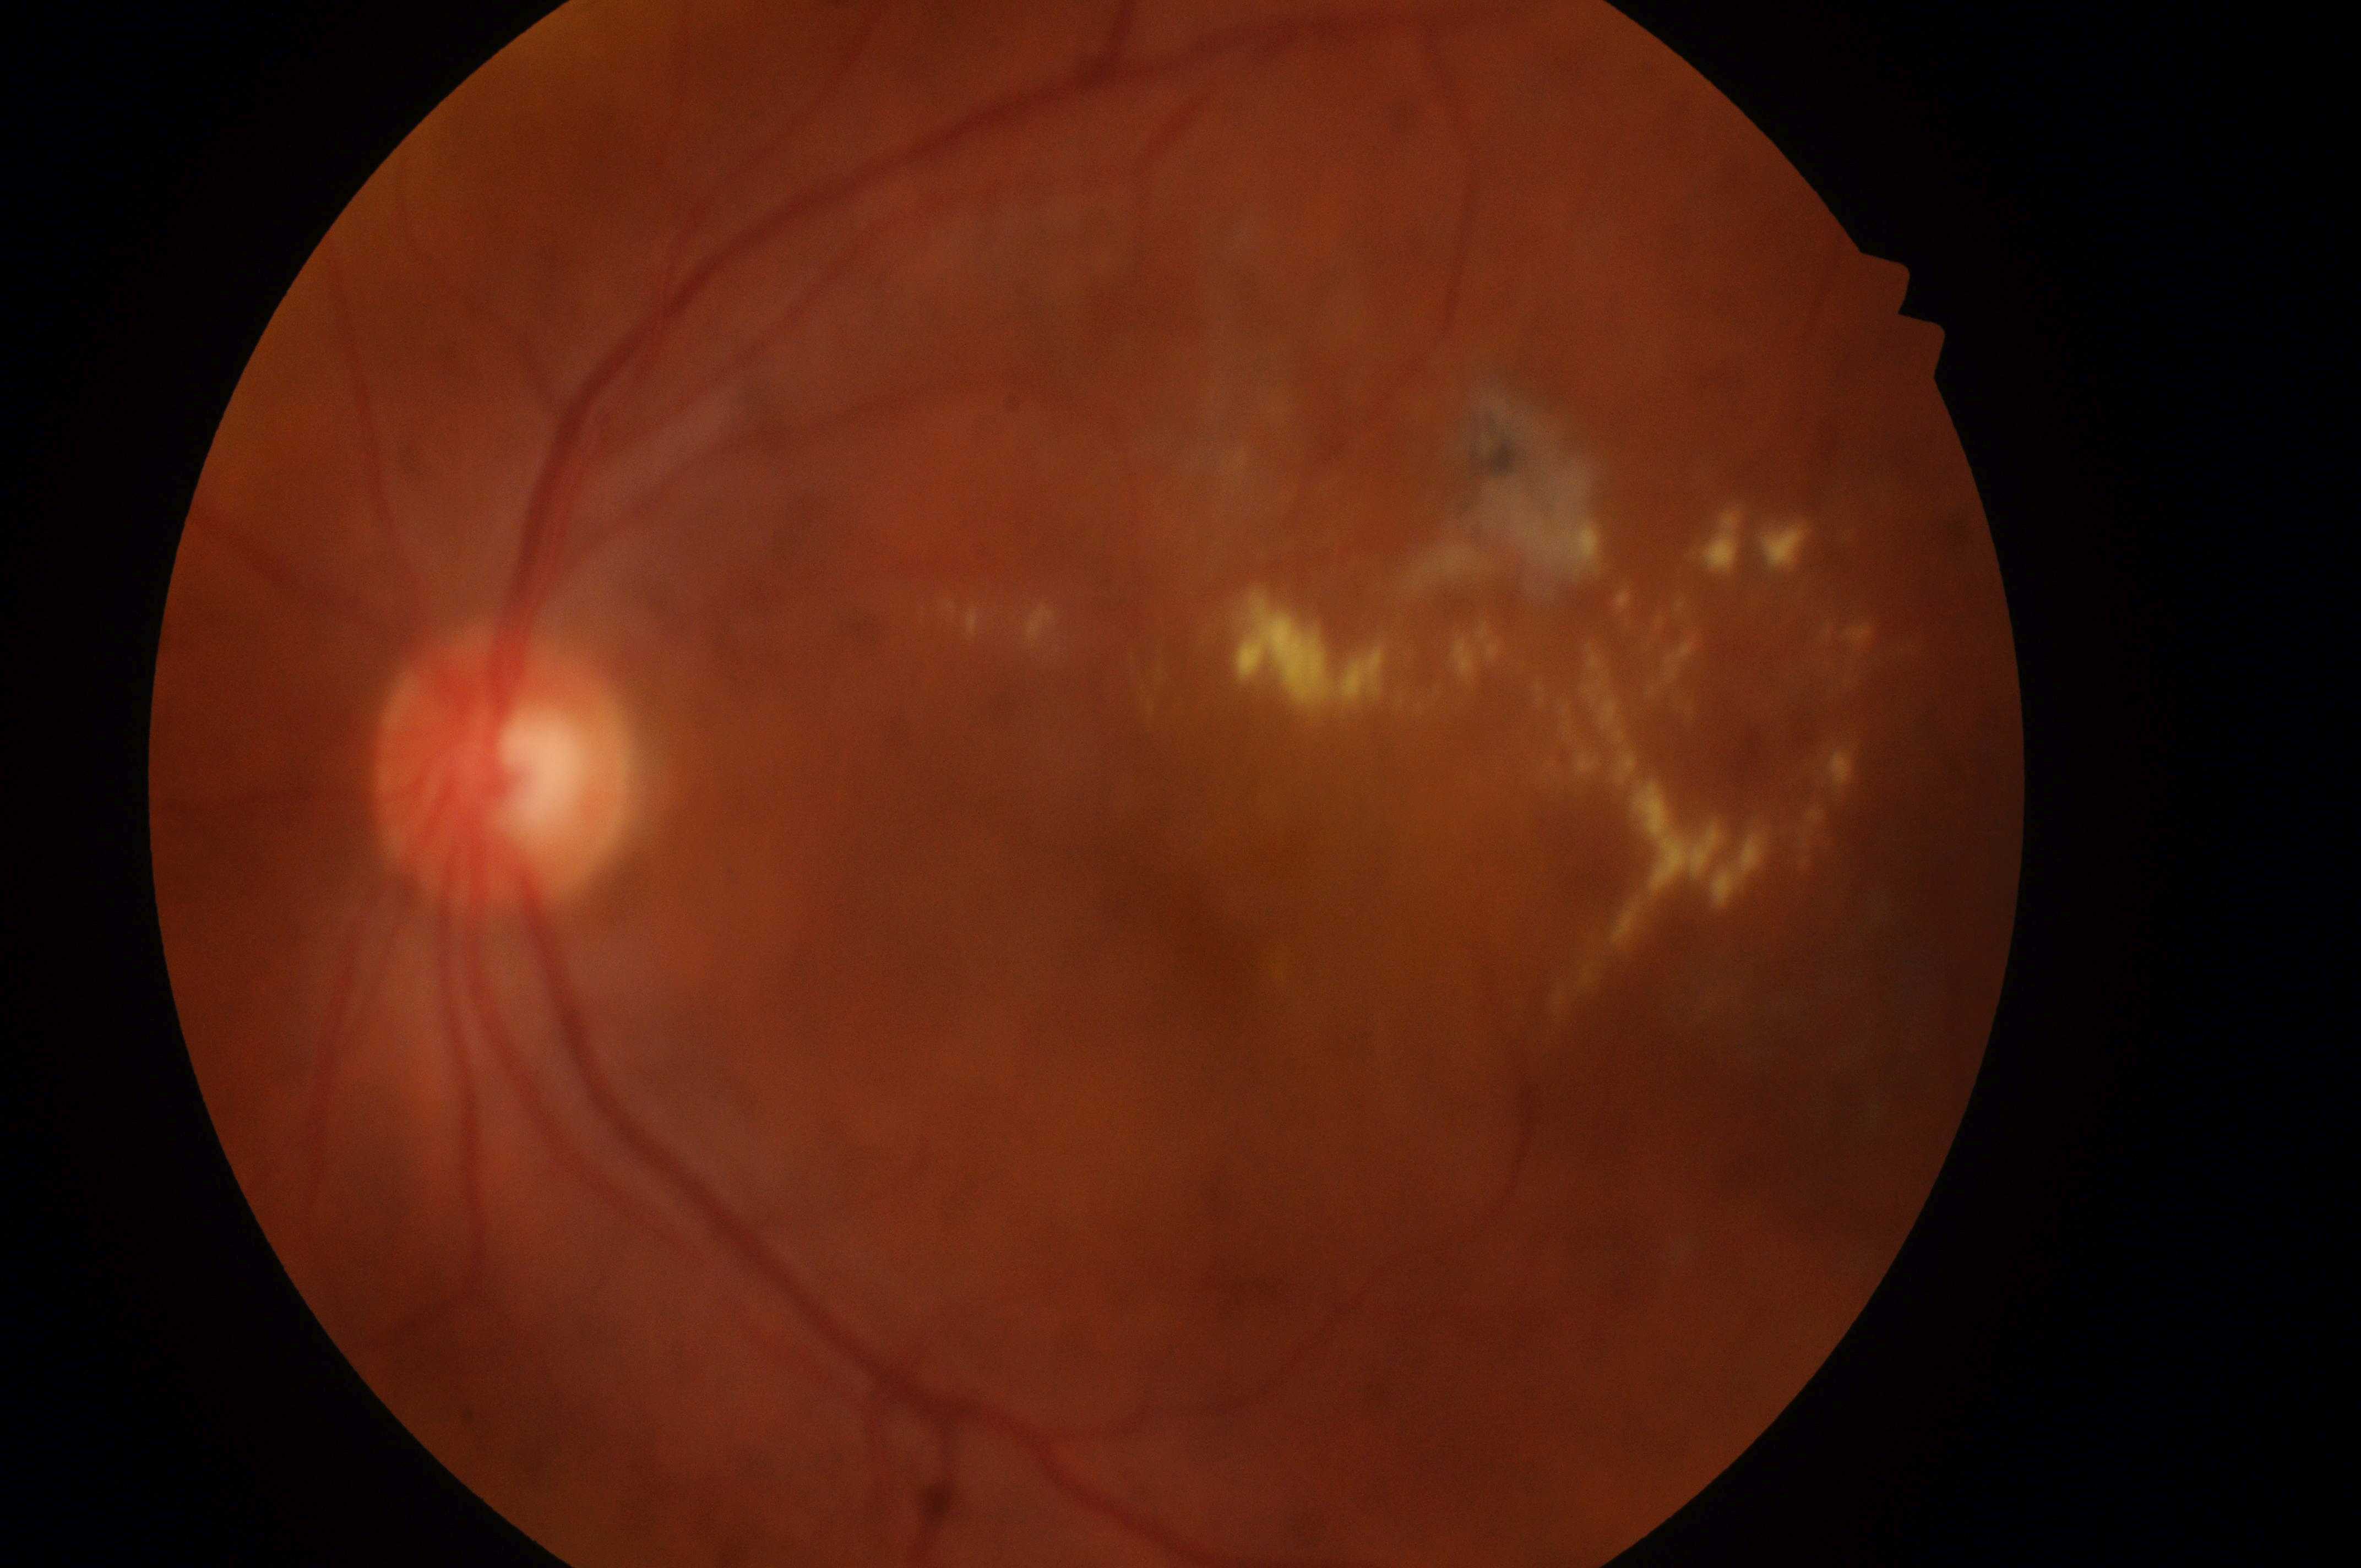 {
  "dr_grade": "2",
  "eye": "left",
  "fovea": "(1211, 907)",
  "dme_grade": "2/2",
  "optic_disc": "(494, 777)"
}